Color fundus image. 45-degree field of view.
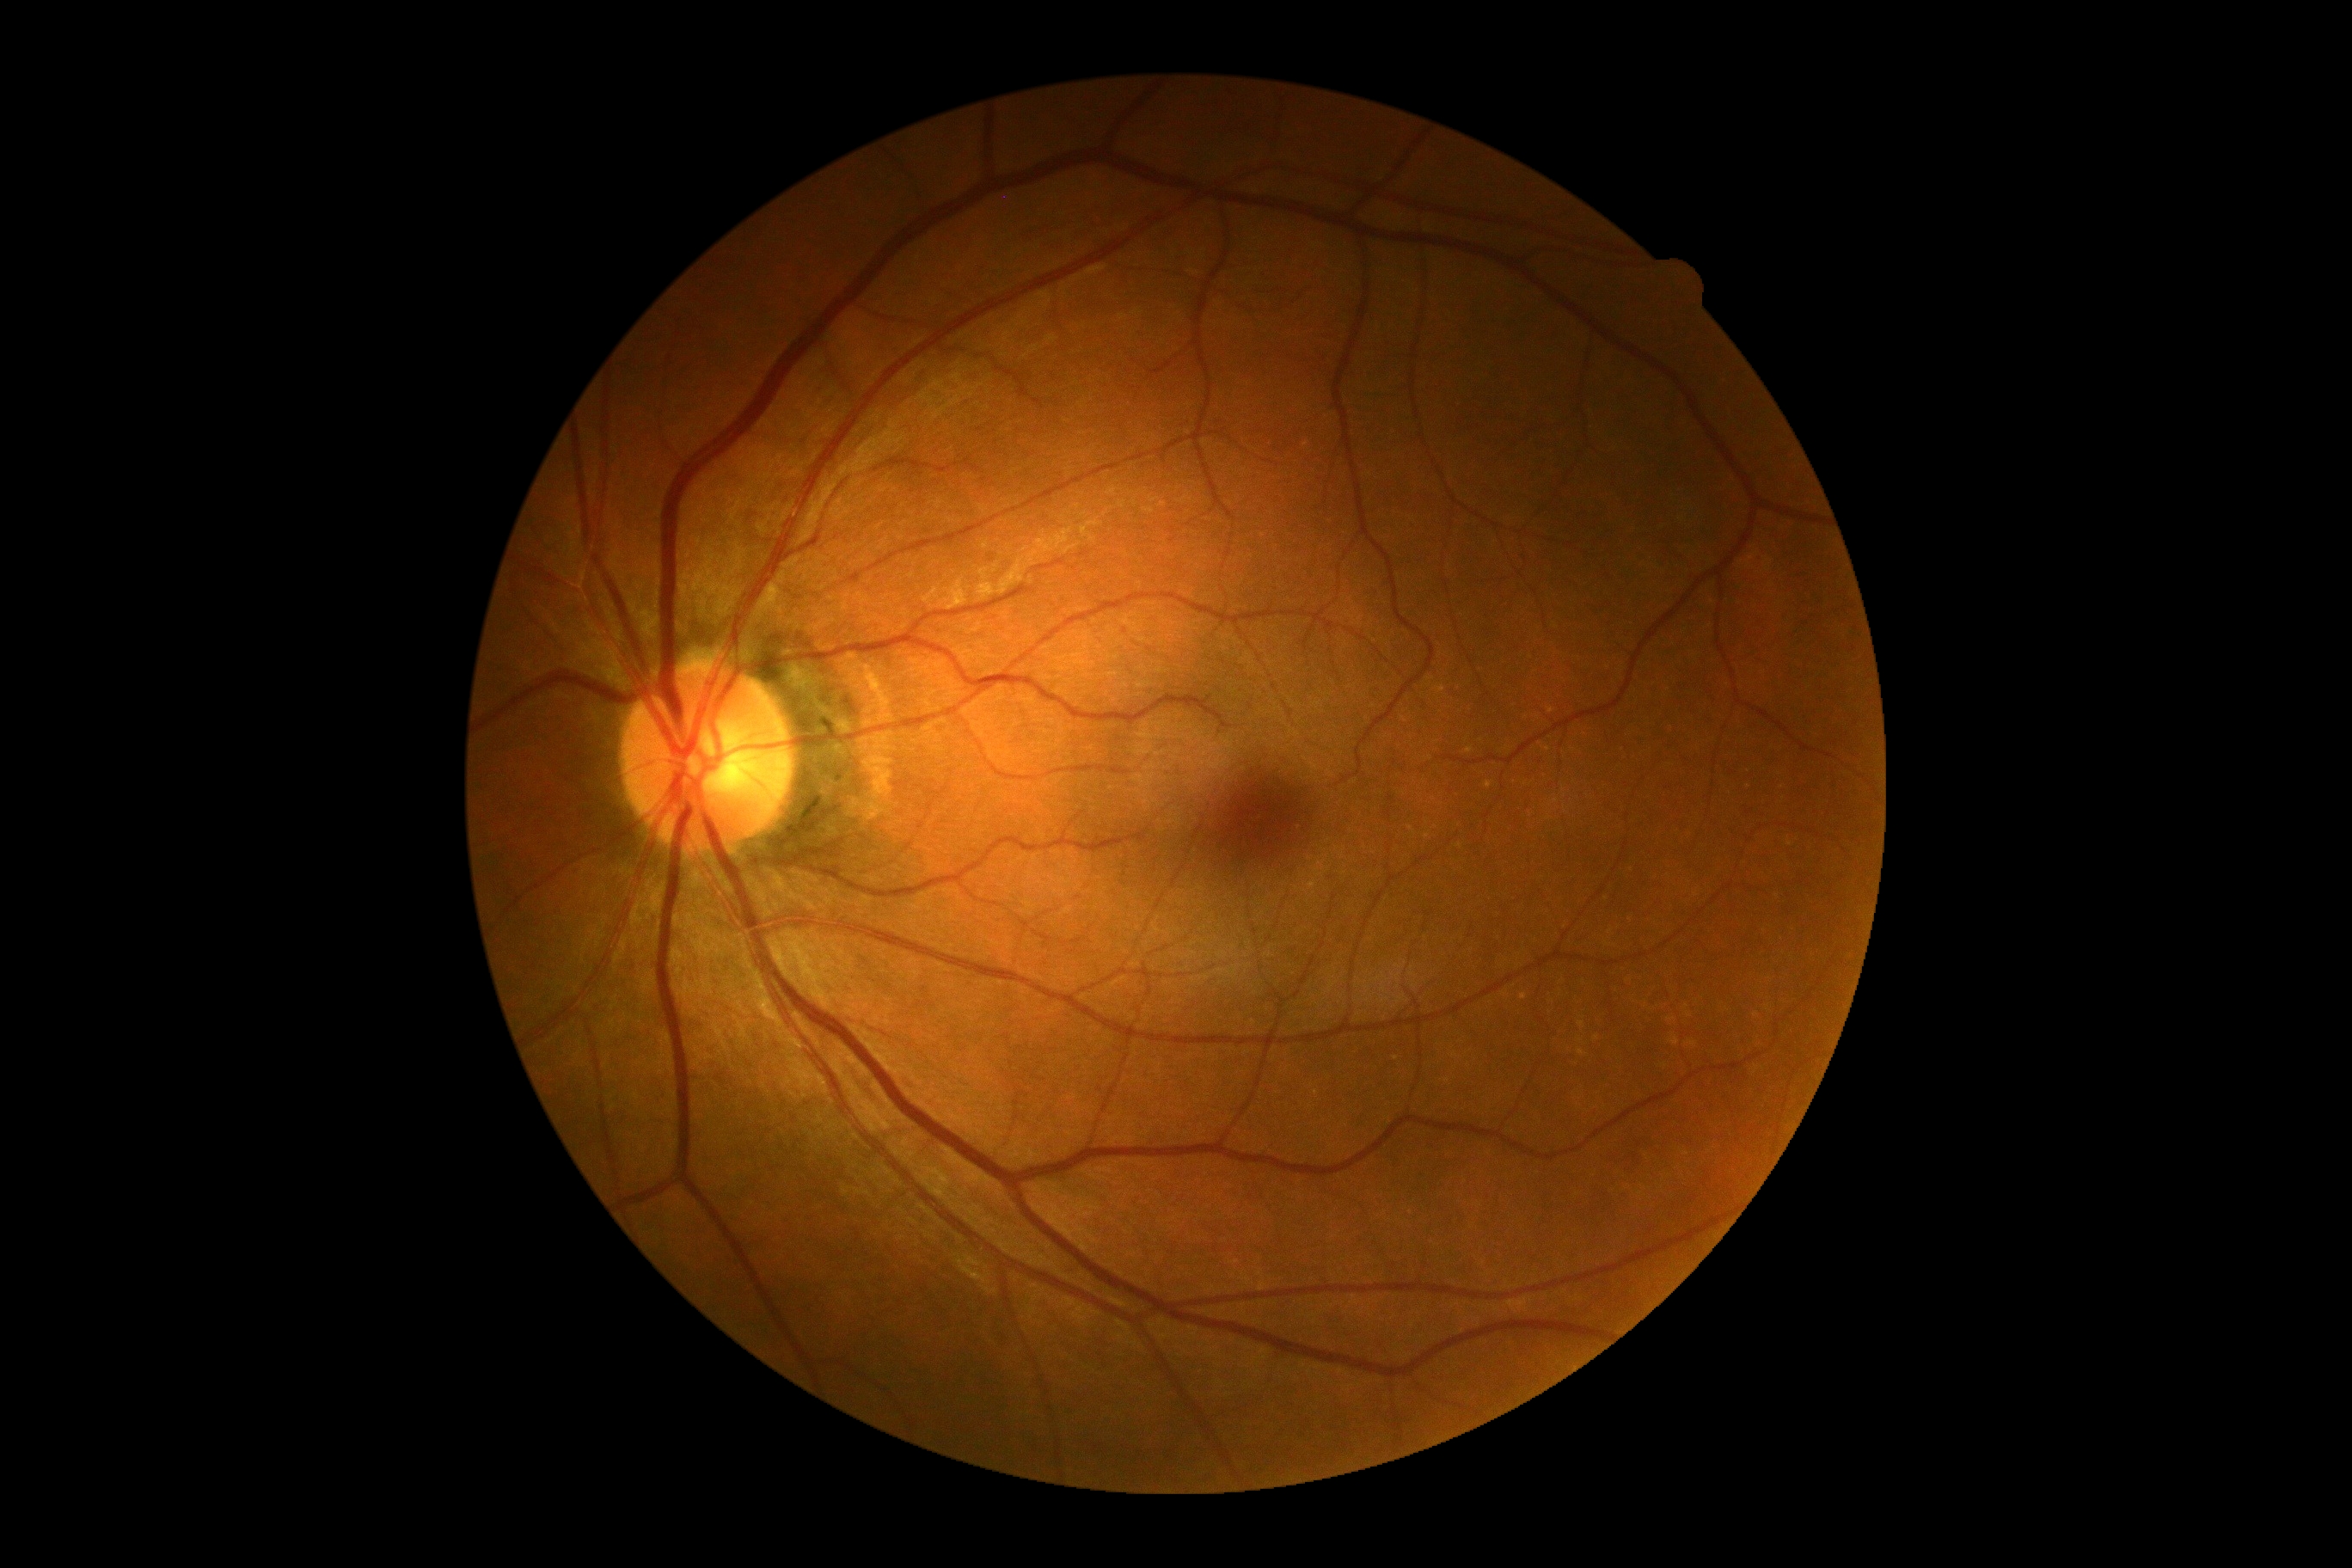 DR impression: no DR findings; DR stage: 0.